45° FOV
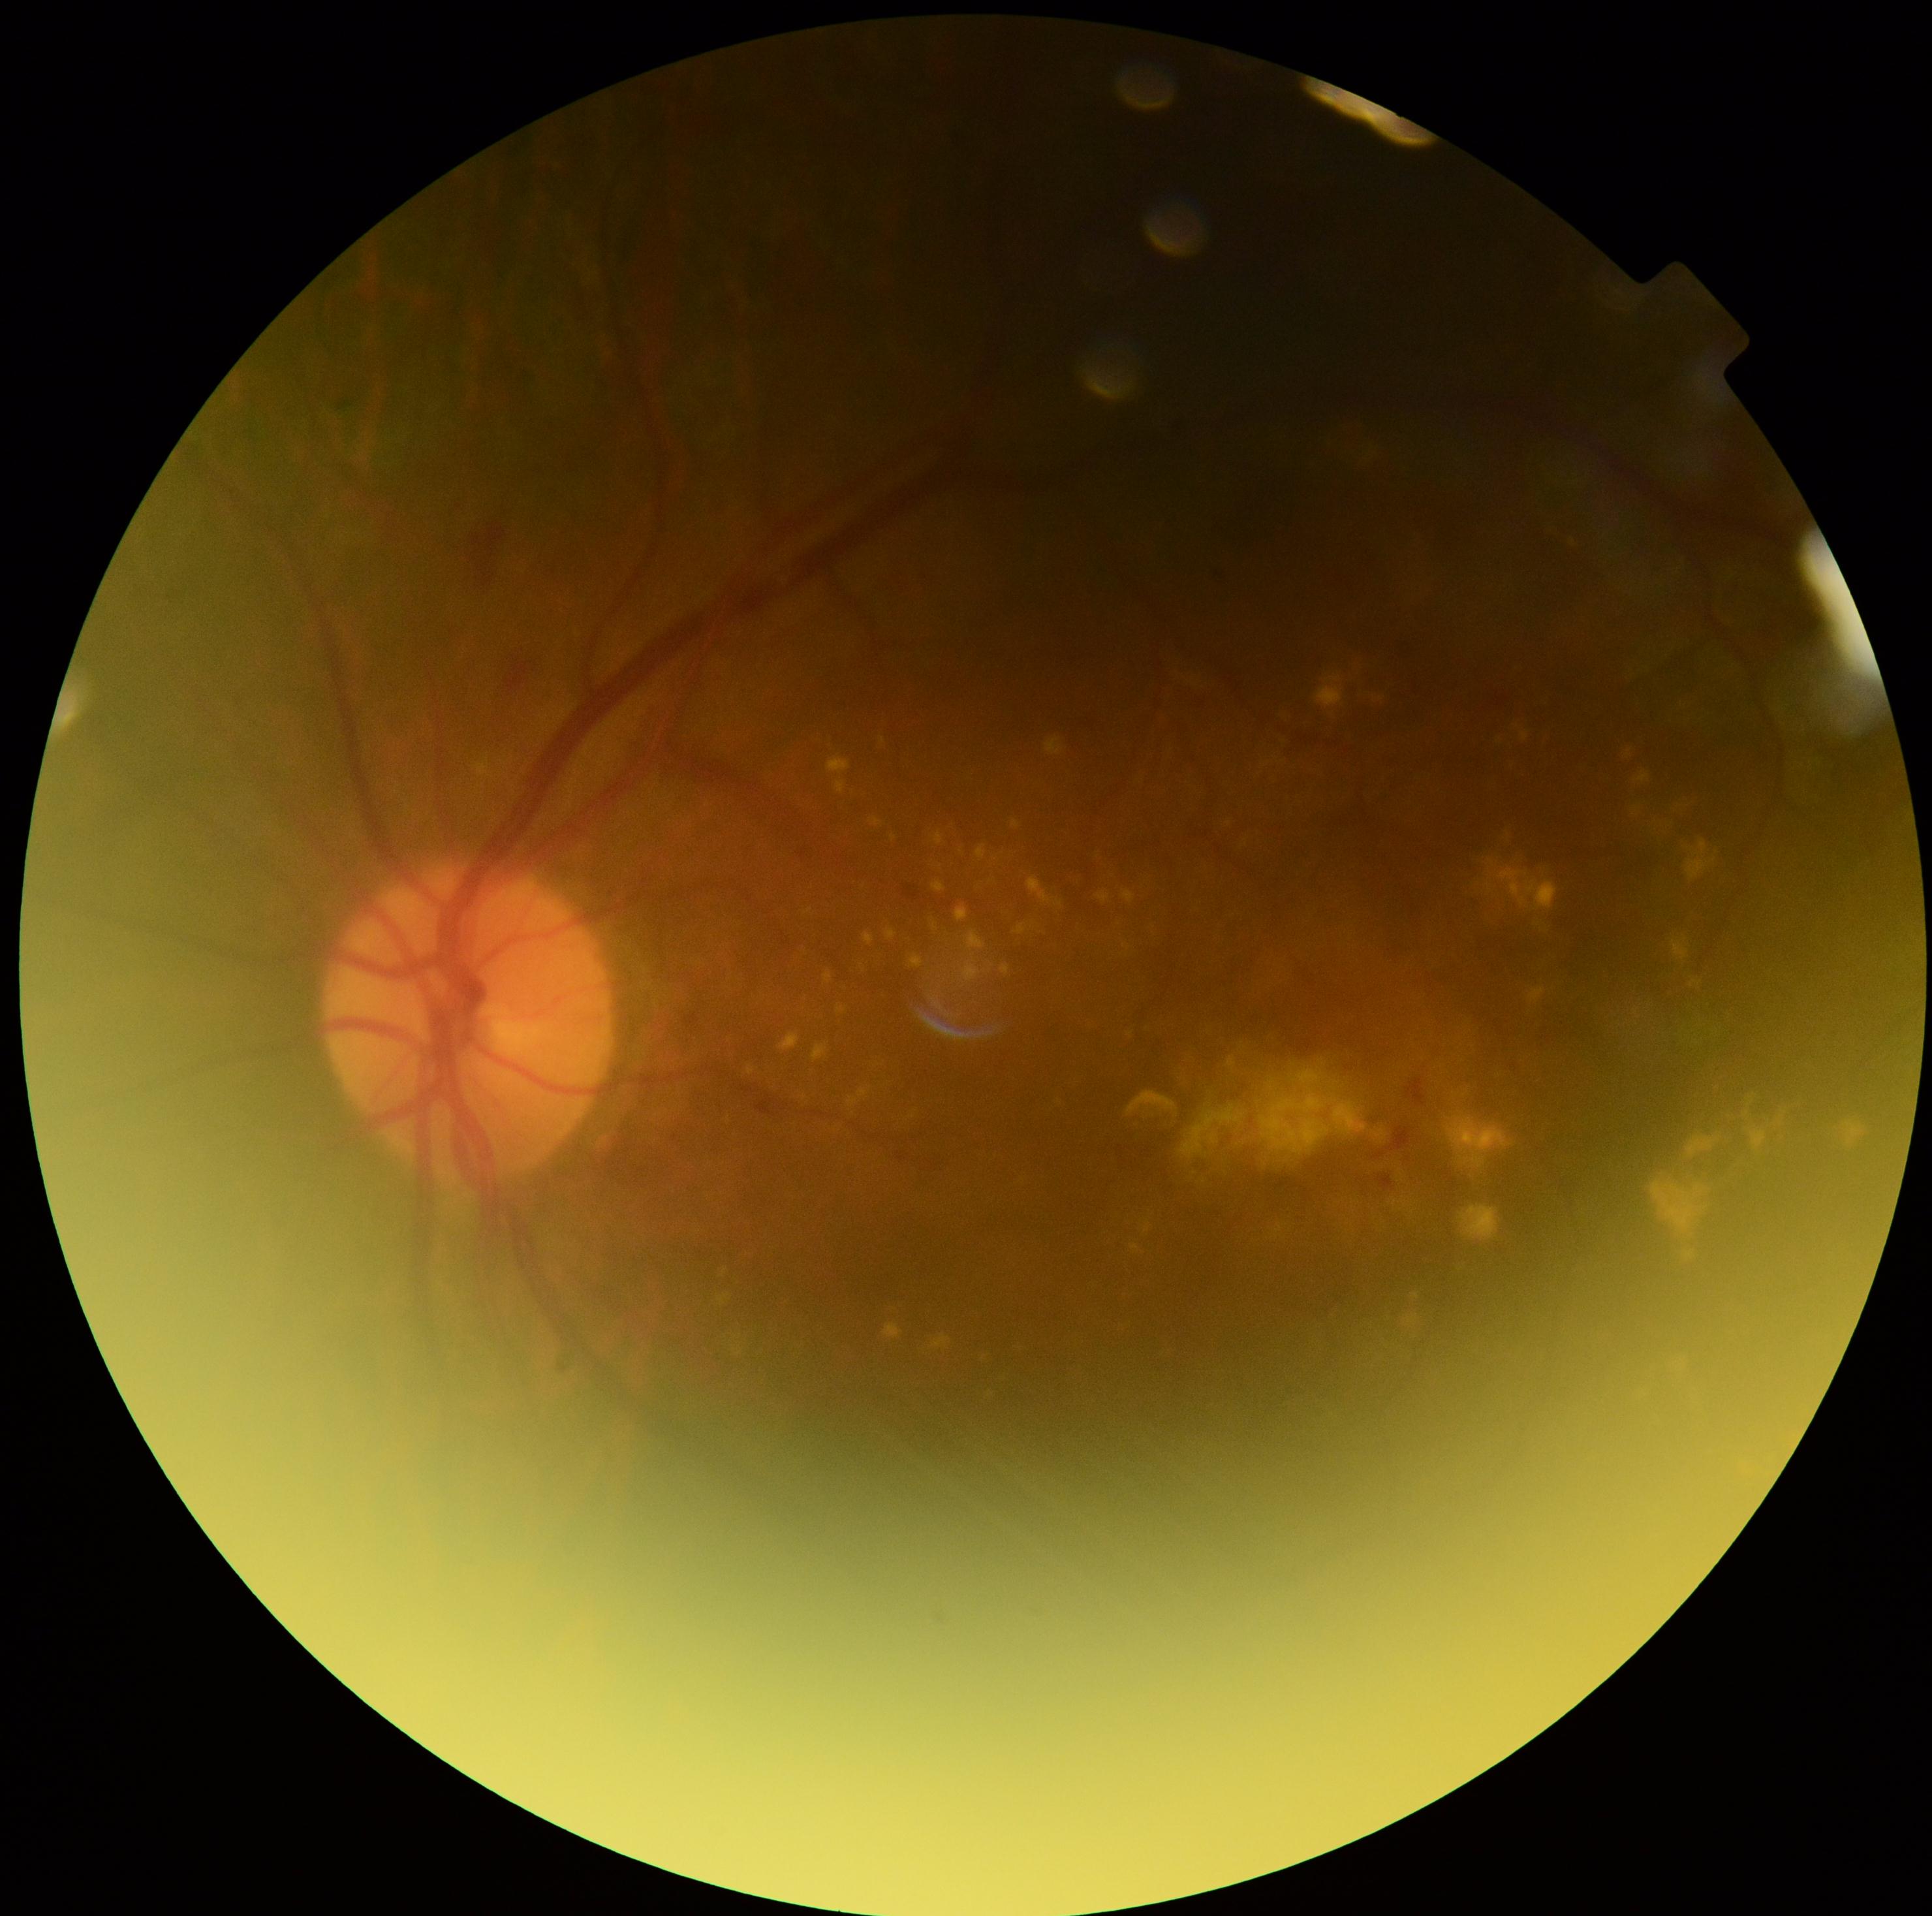 DR is moderate non-proliferative diabetic retinopathy (grade 2). Disease class: non-proliferative diabetic retinopathy.